Fundus photo; image size 2212x1659.
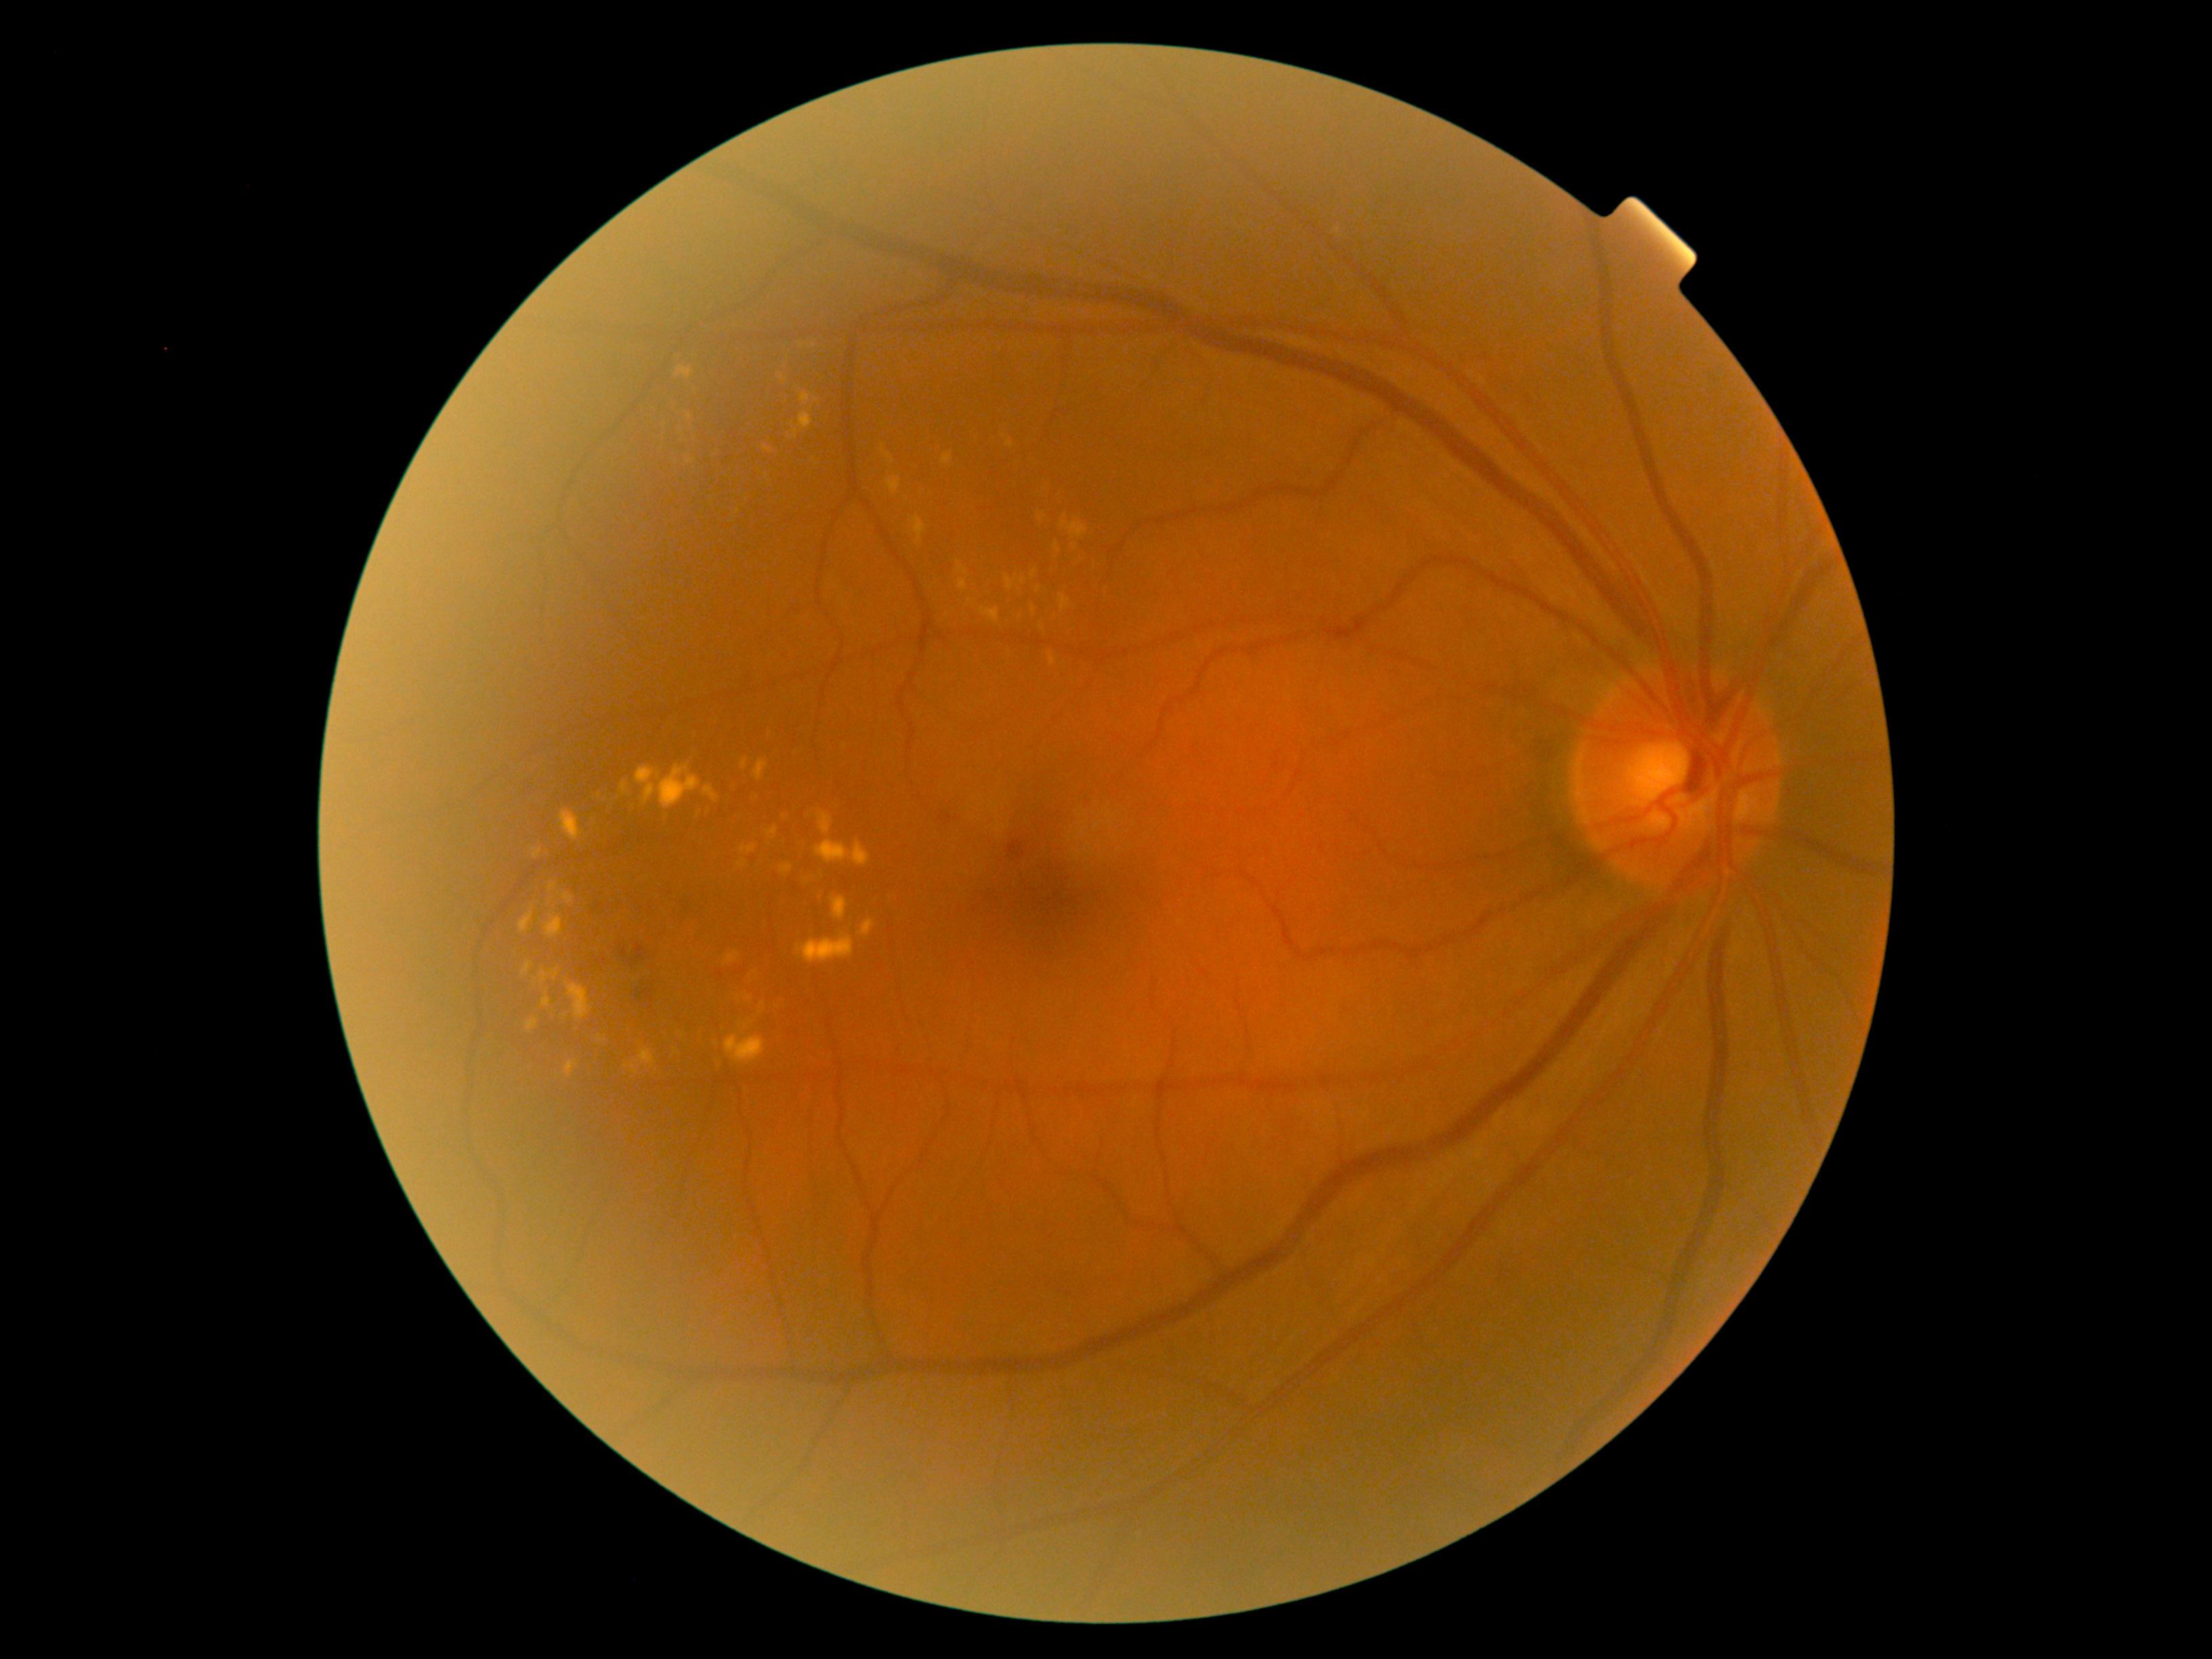

<lesions partial="true">
  <dr_grade>2</dr_grade>
  <ex partial="true">(left=746, top=792, right=757, bottom=803), (left=527, top=1020, right=539, bottom=1031), (left=800, top=392, right=813, bottom=405), (left=677, top=367, right=695, bottom=380), (left=712, top=1055, right=727, bottom=1078), (left=560, top=810, right=582, bottom=841), (left=1048, top=653, right=1057, bottom=666), (left=739, top=1023, right=747, bottom=1031), (left=1055, top=544, right=1061, bottom=552), (left=981, top=607, right=1000, bottom=623), (left=687, top=460, right=696, bottom=466), (left=798, top=933, right=855, bottom=964), (left=703, top=785, right=719, bottom=802), (left=565, top=1061, right=578, bottom=1076), (left=762, top=445, right=773, bottom=453)</ex>
  <ex_small>[1074, 546], [801, 346], [659, 776], [1039, 589], [716, 1044]</ex_small>
</lesions>